Retinal fundus photograph. Image size 1932x1932. 45° field of view — 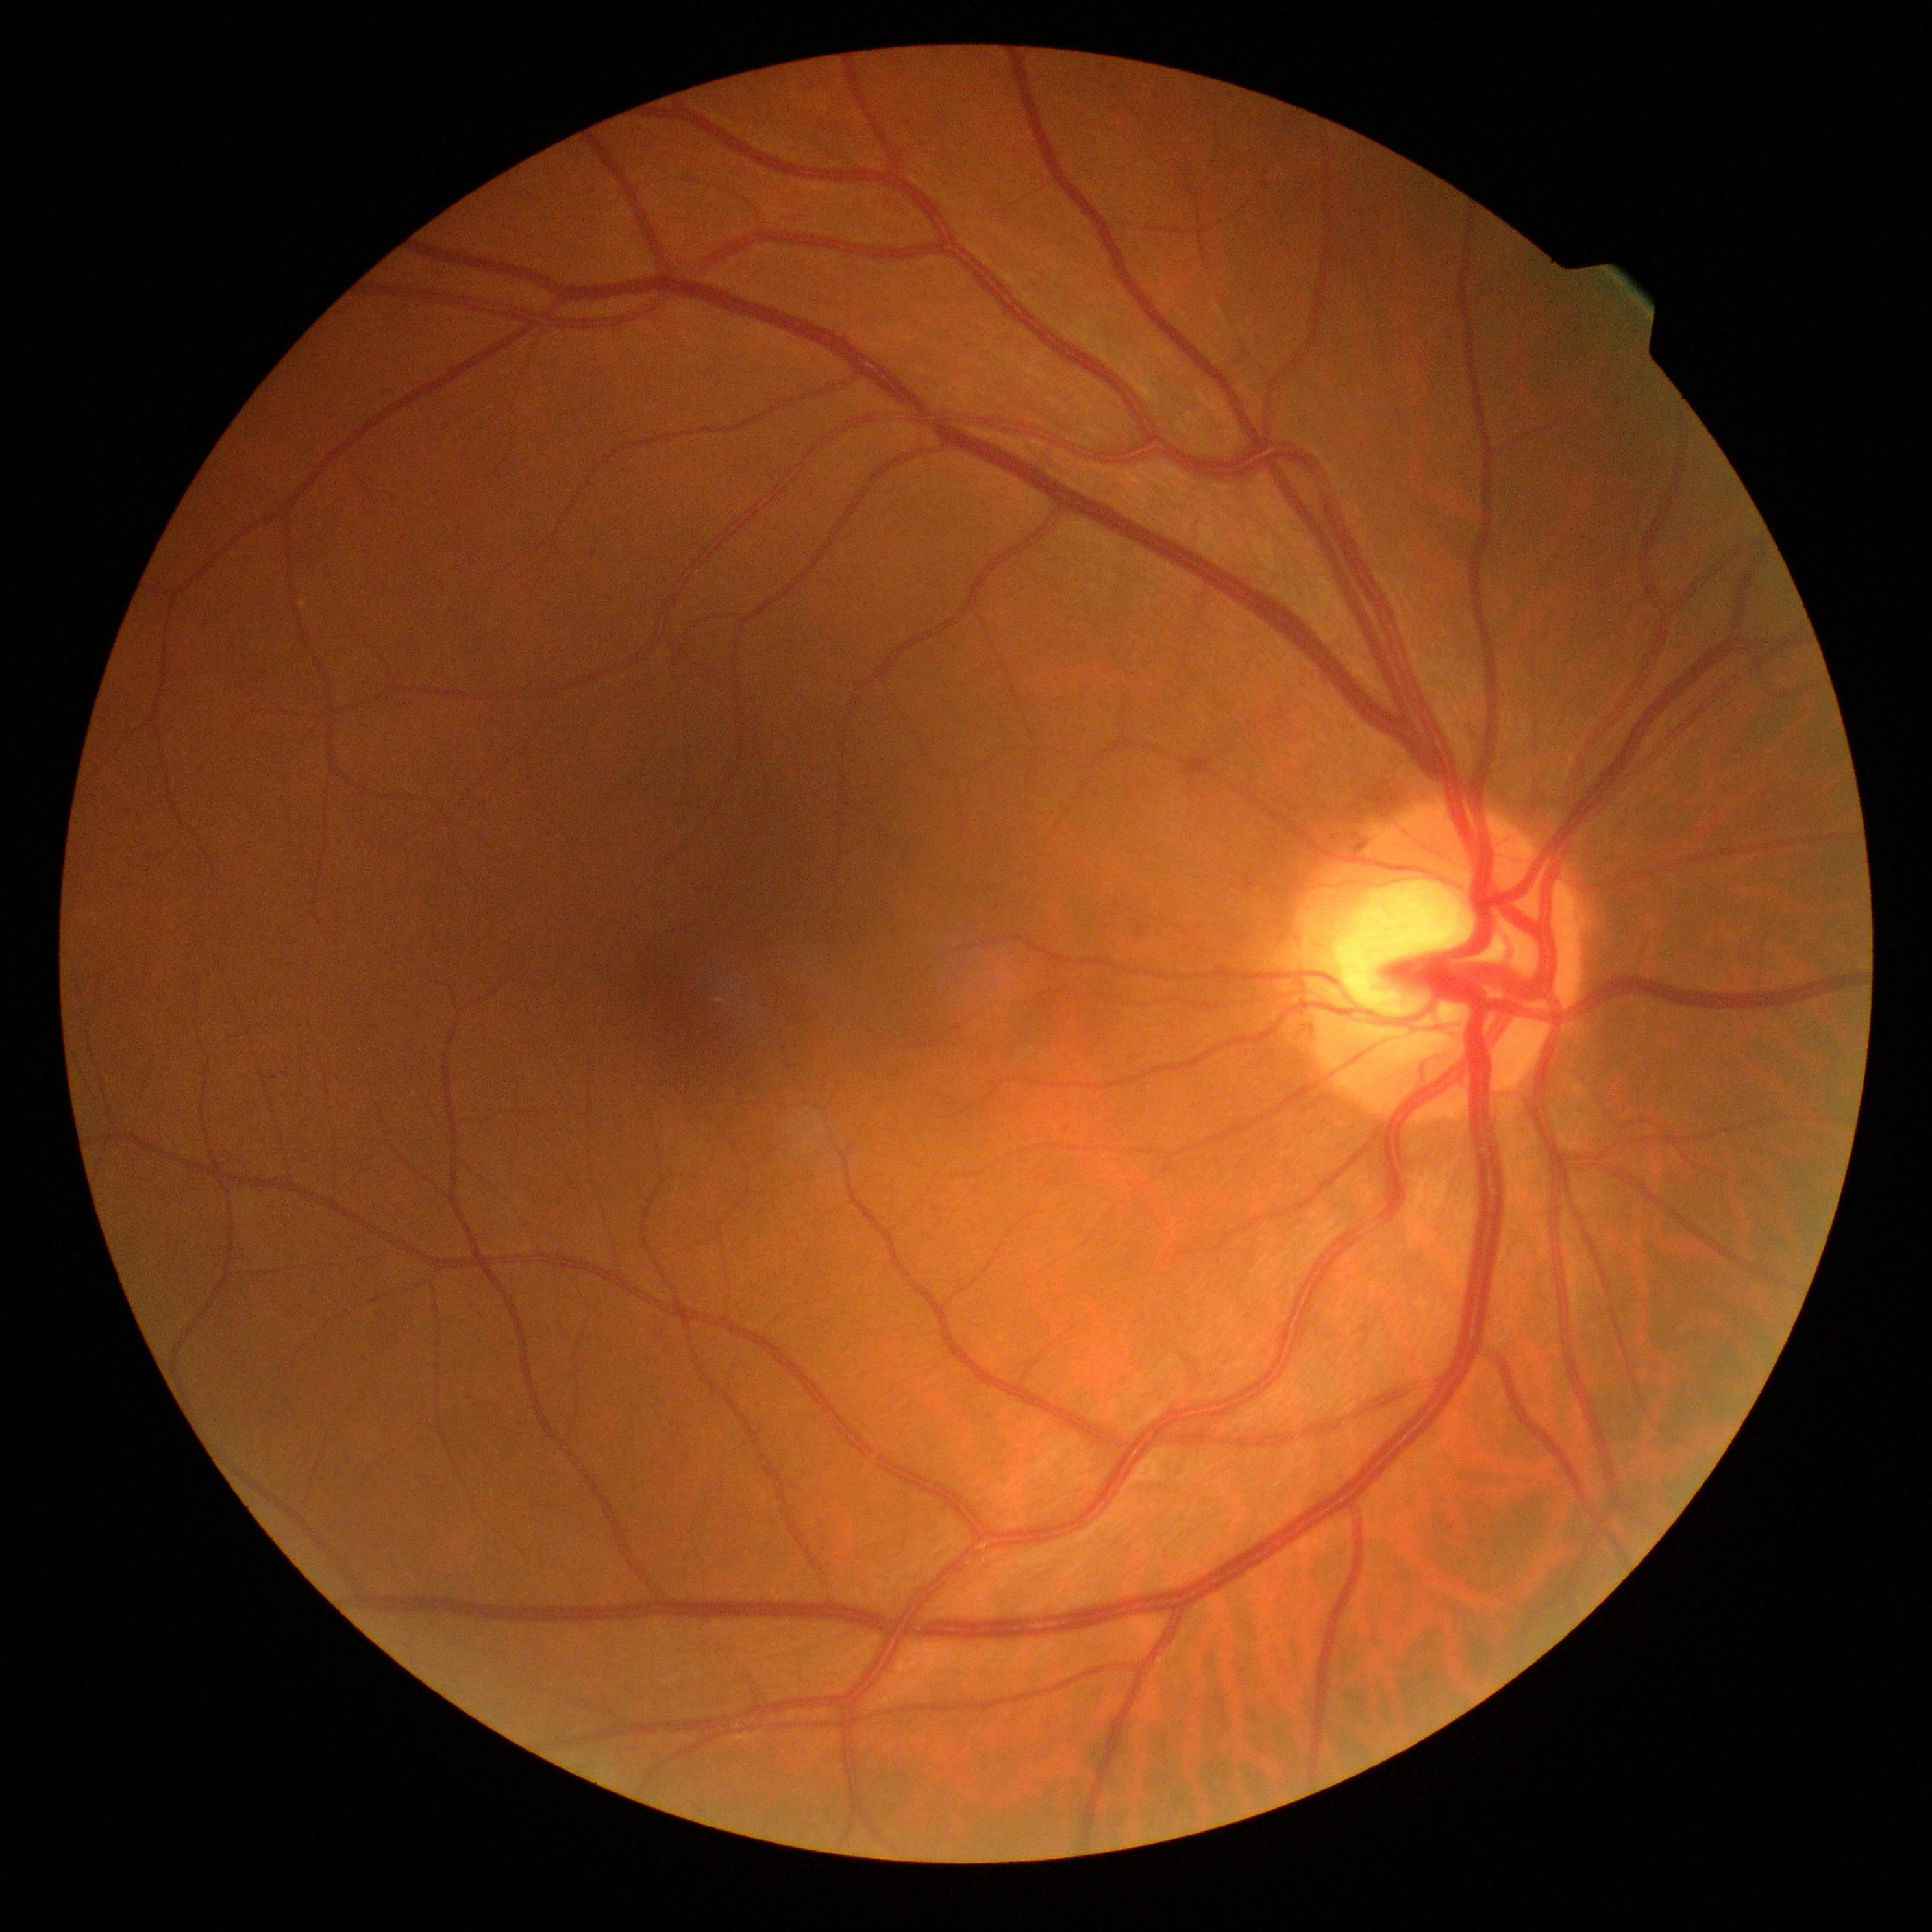

DR class: non-proliferative diabetic retinopathy | diabetic retinopathy: moderate non-proliferative diabetic retinopathy (grade 2) — more than just microaneurysms but less than severe NPDR.